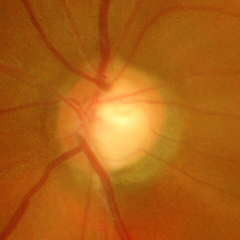
Glaucoma is present.
Severe glaucomatous damage.
Diagnostic criteria: near-total cupping of the optic nerve head, with or without severe visual field loss within the central 10 degrees of fixation.